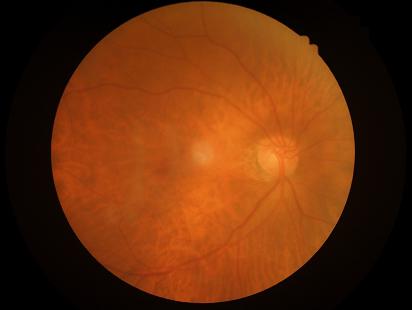 overall_quality: good, gradable
illumination: uniform, no color cast